Color fundus photograph; FOV: 45 degrees; 2048x1536px:
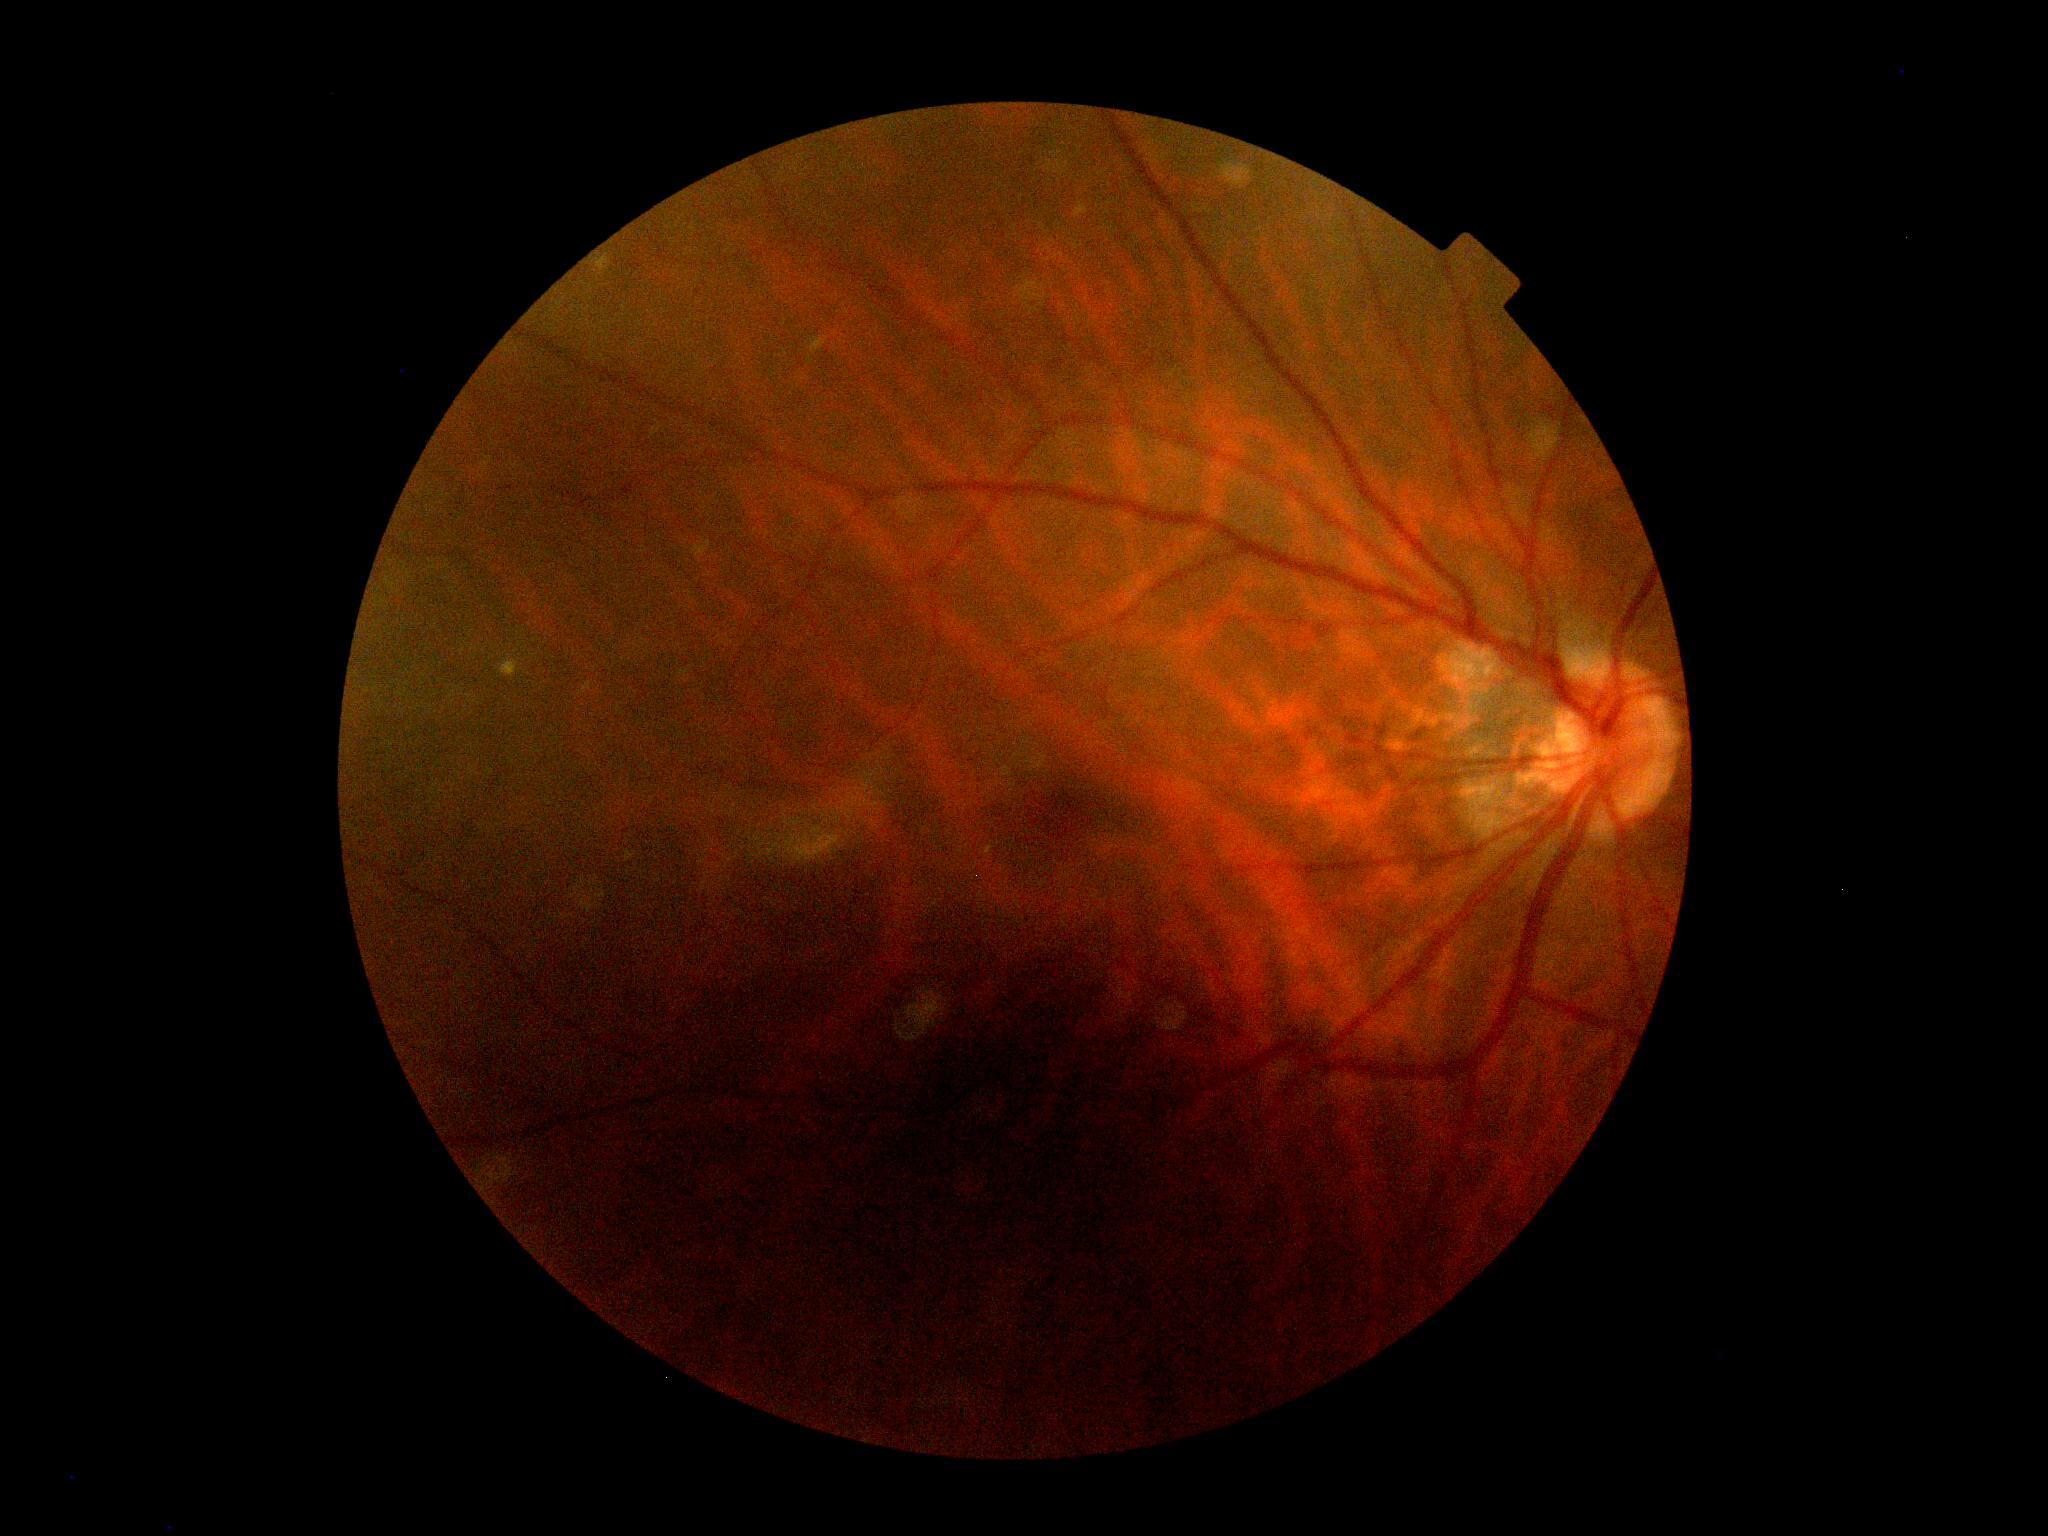

DR grade: 0. No DR findings.